Captured with the Phoenix ICON (100° field of view) · wide-field contact fundus photograph of an infant.
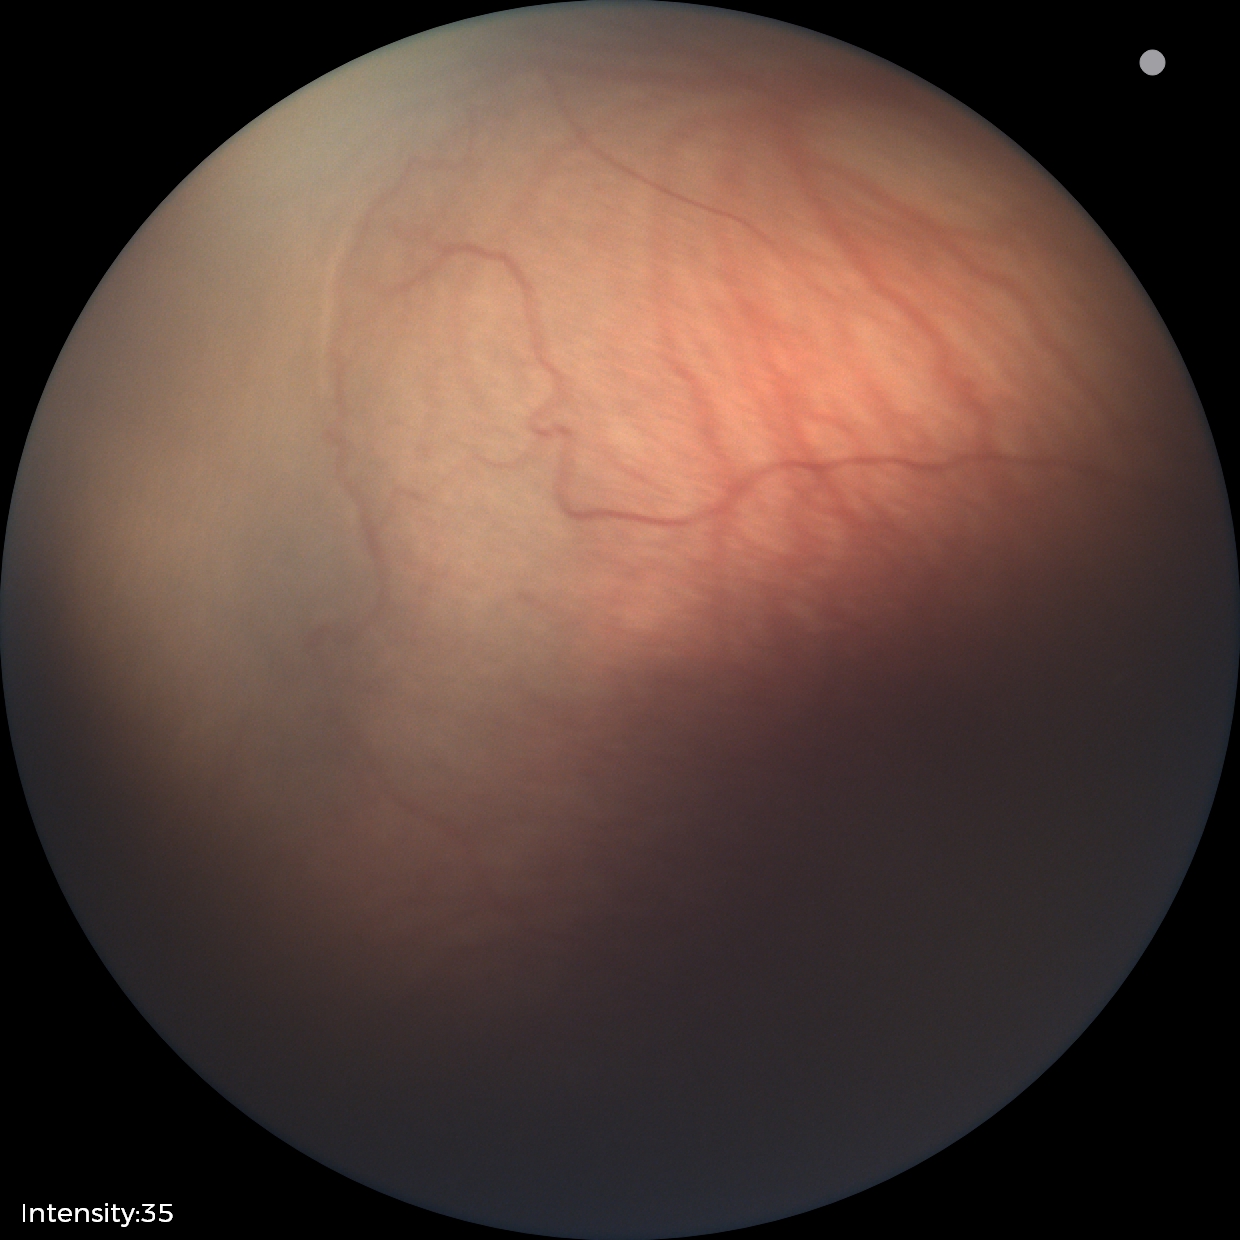 Diagnosis from this screening exam: retinopathy of prematurity stage 1.